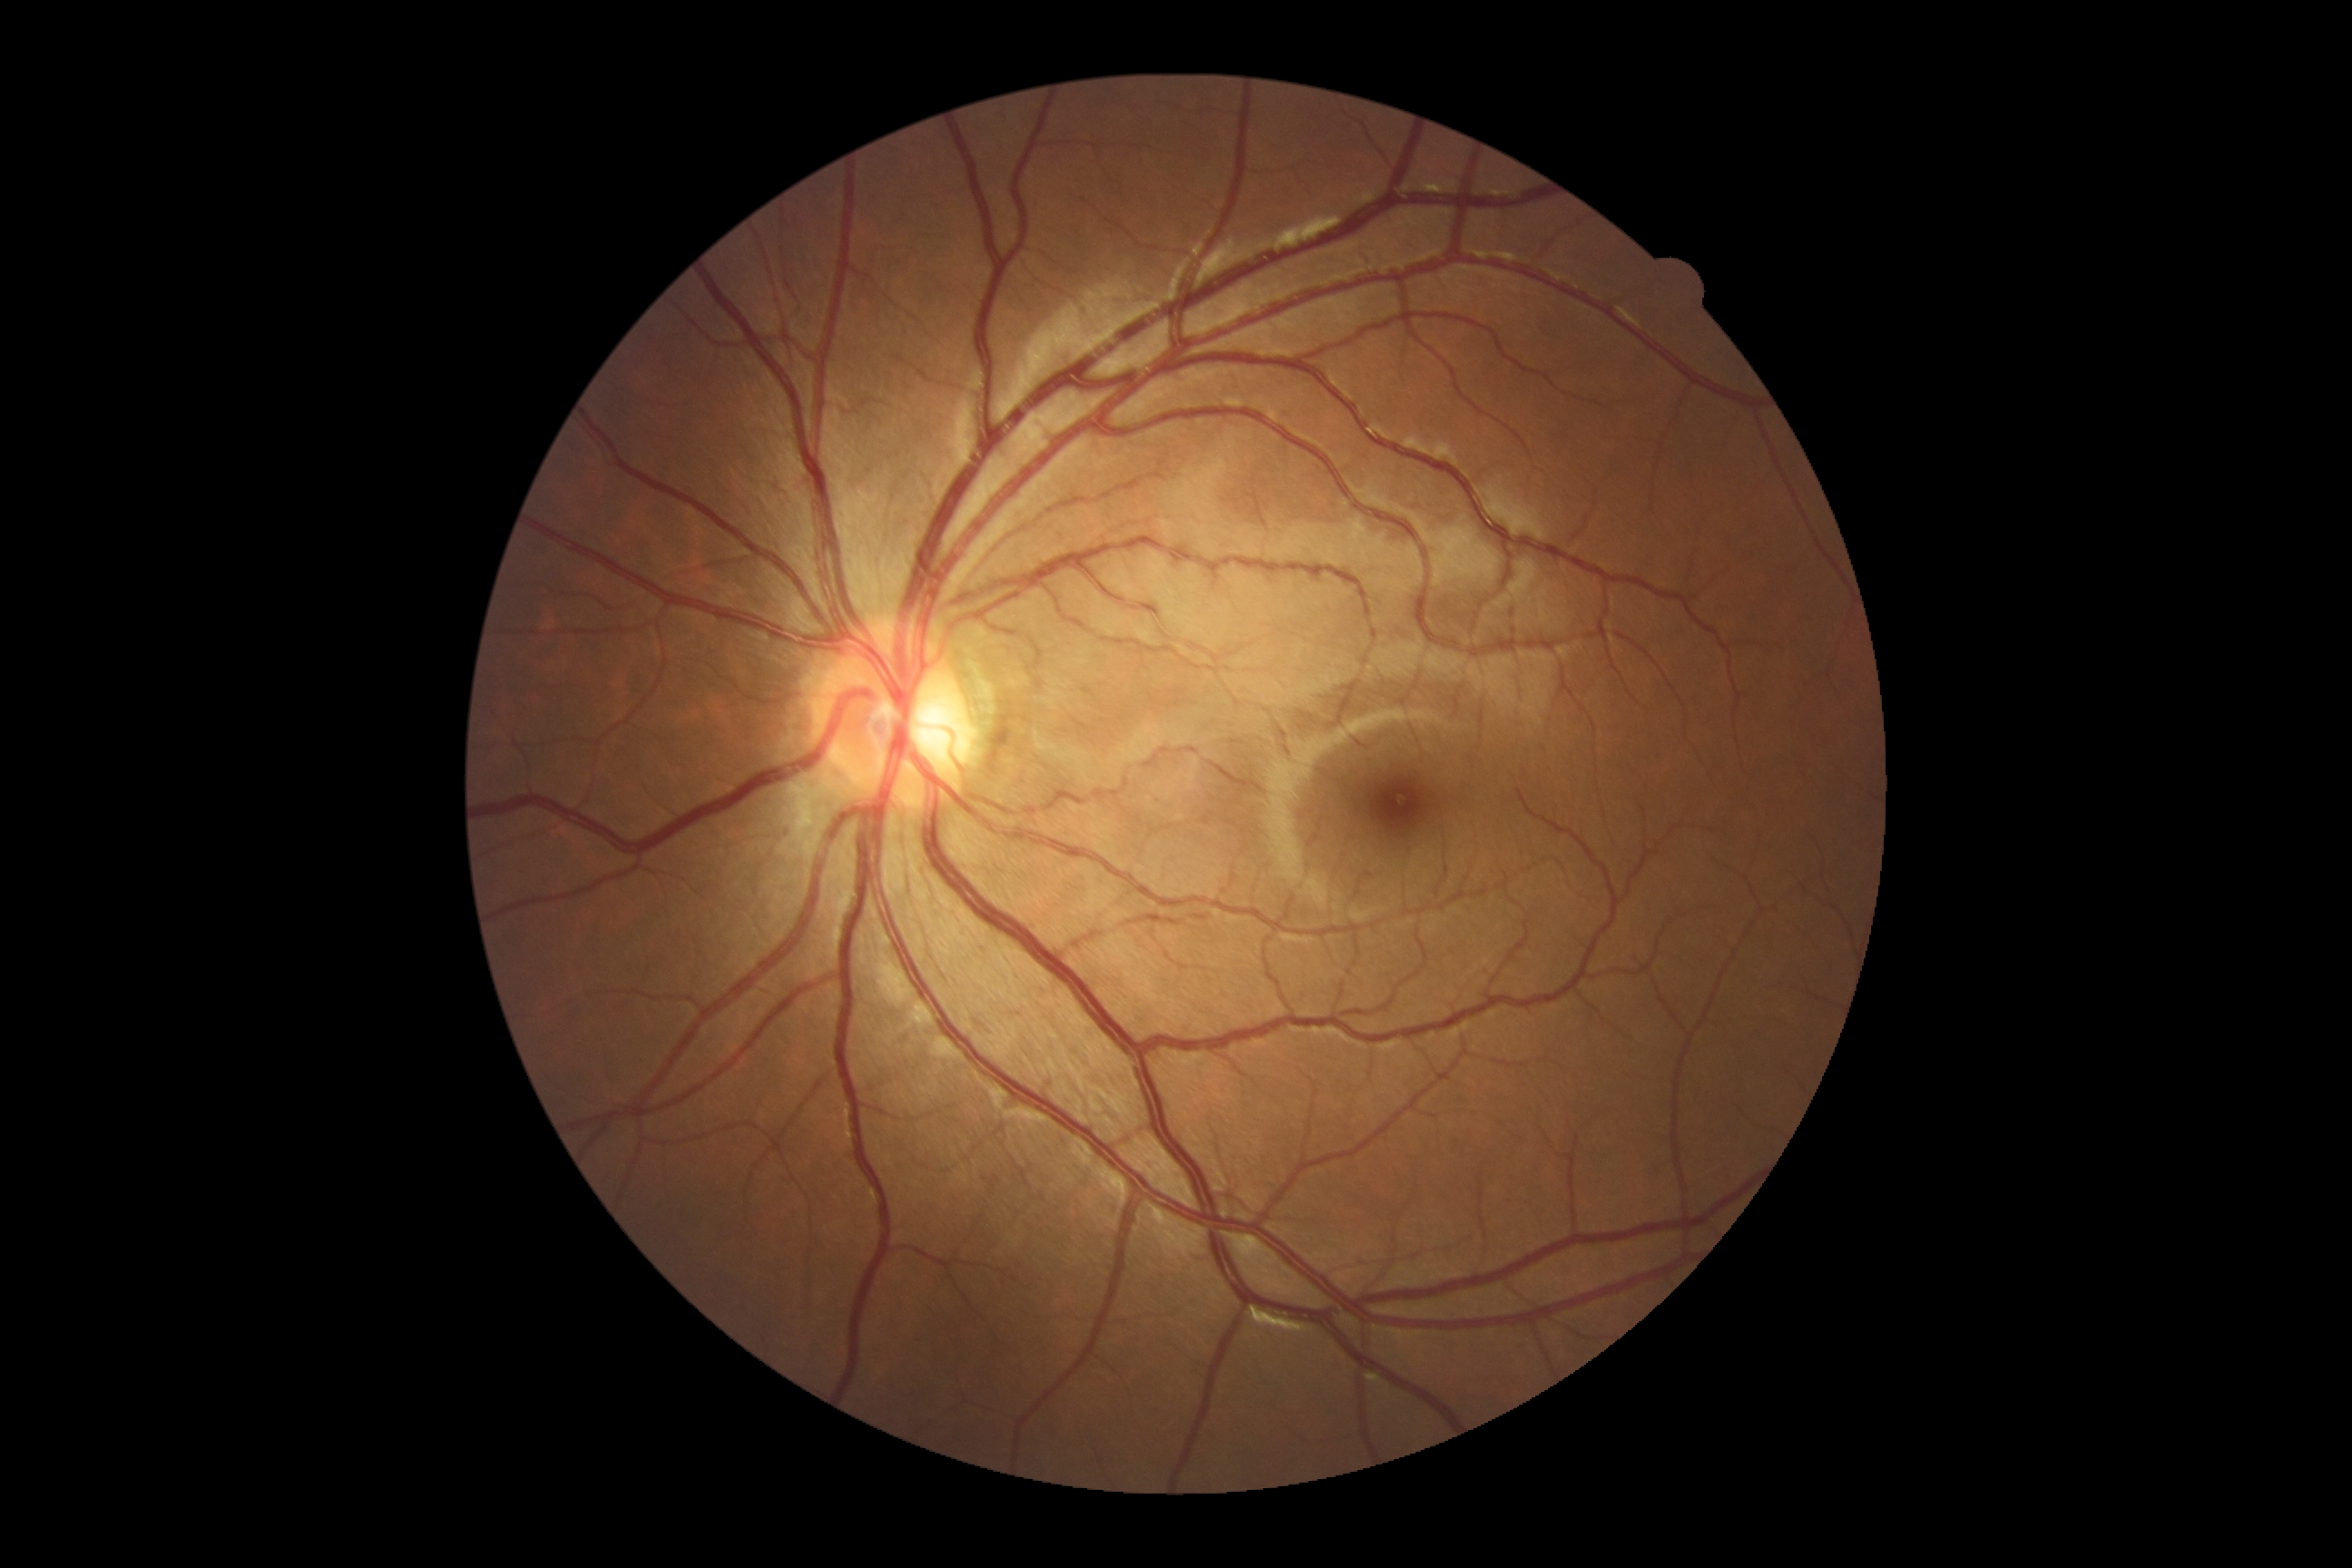
Findings:
• DR grade: 0